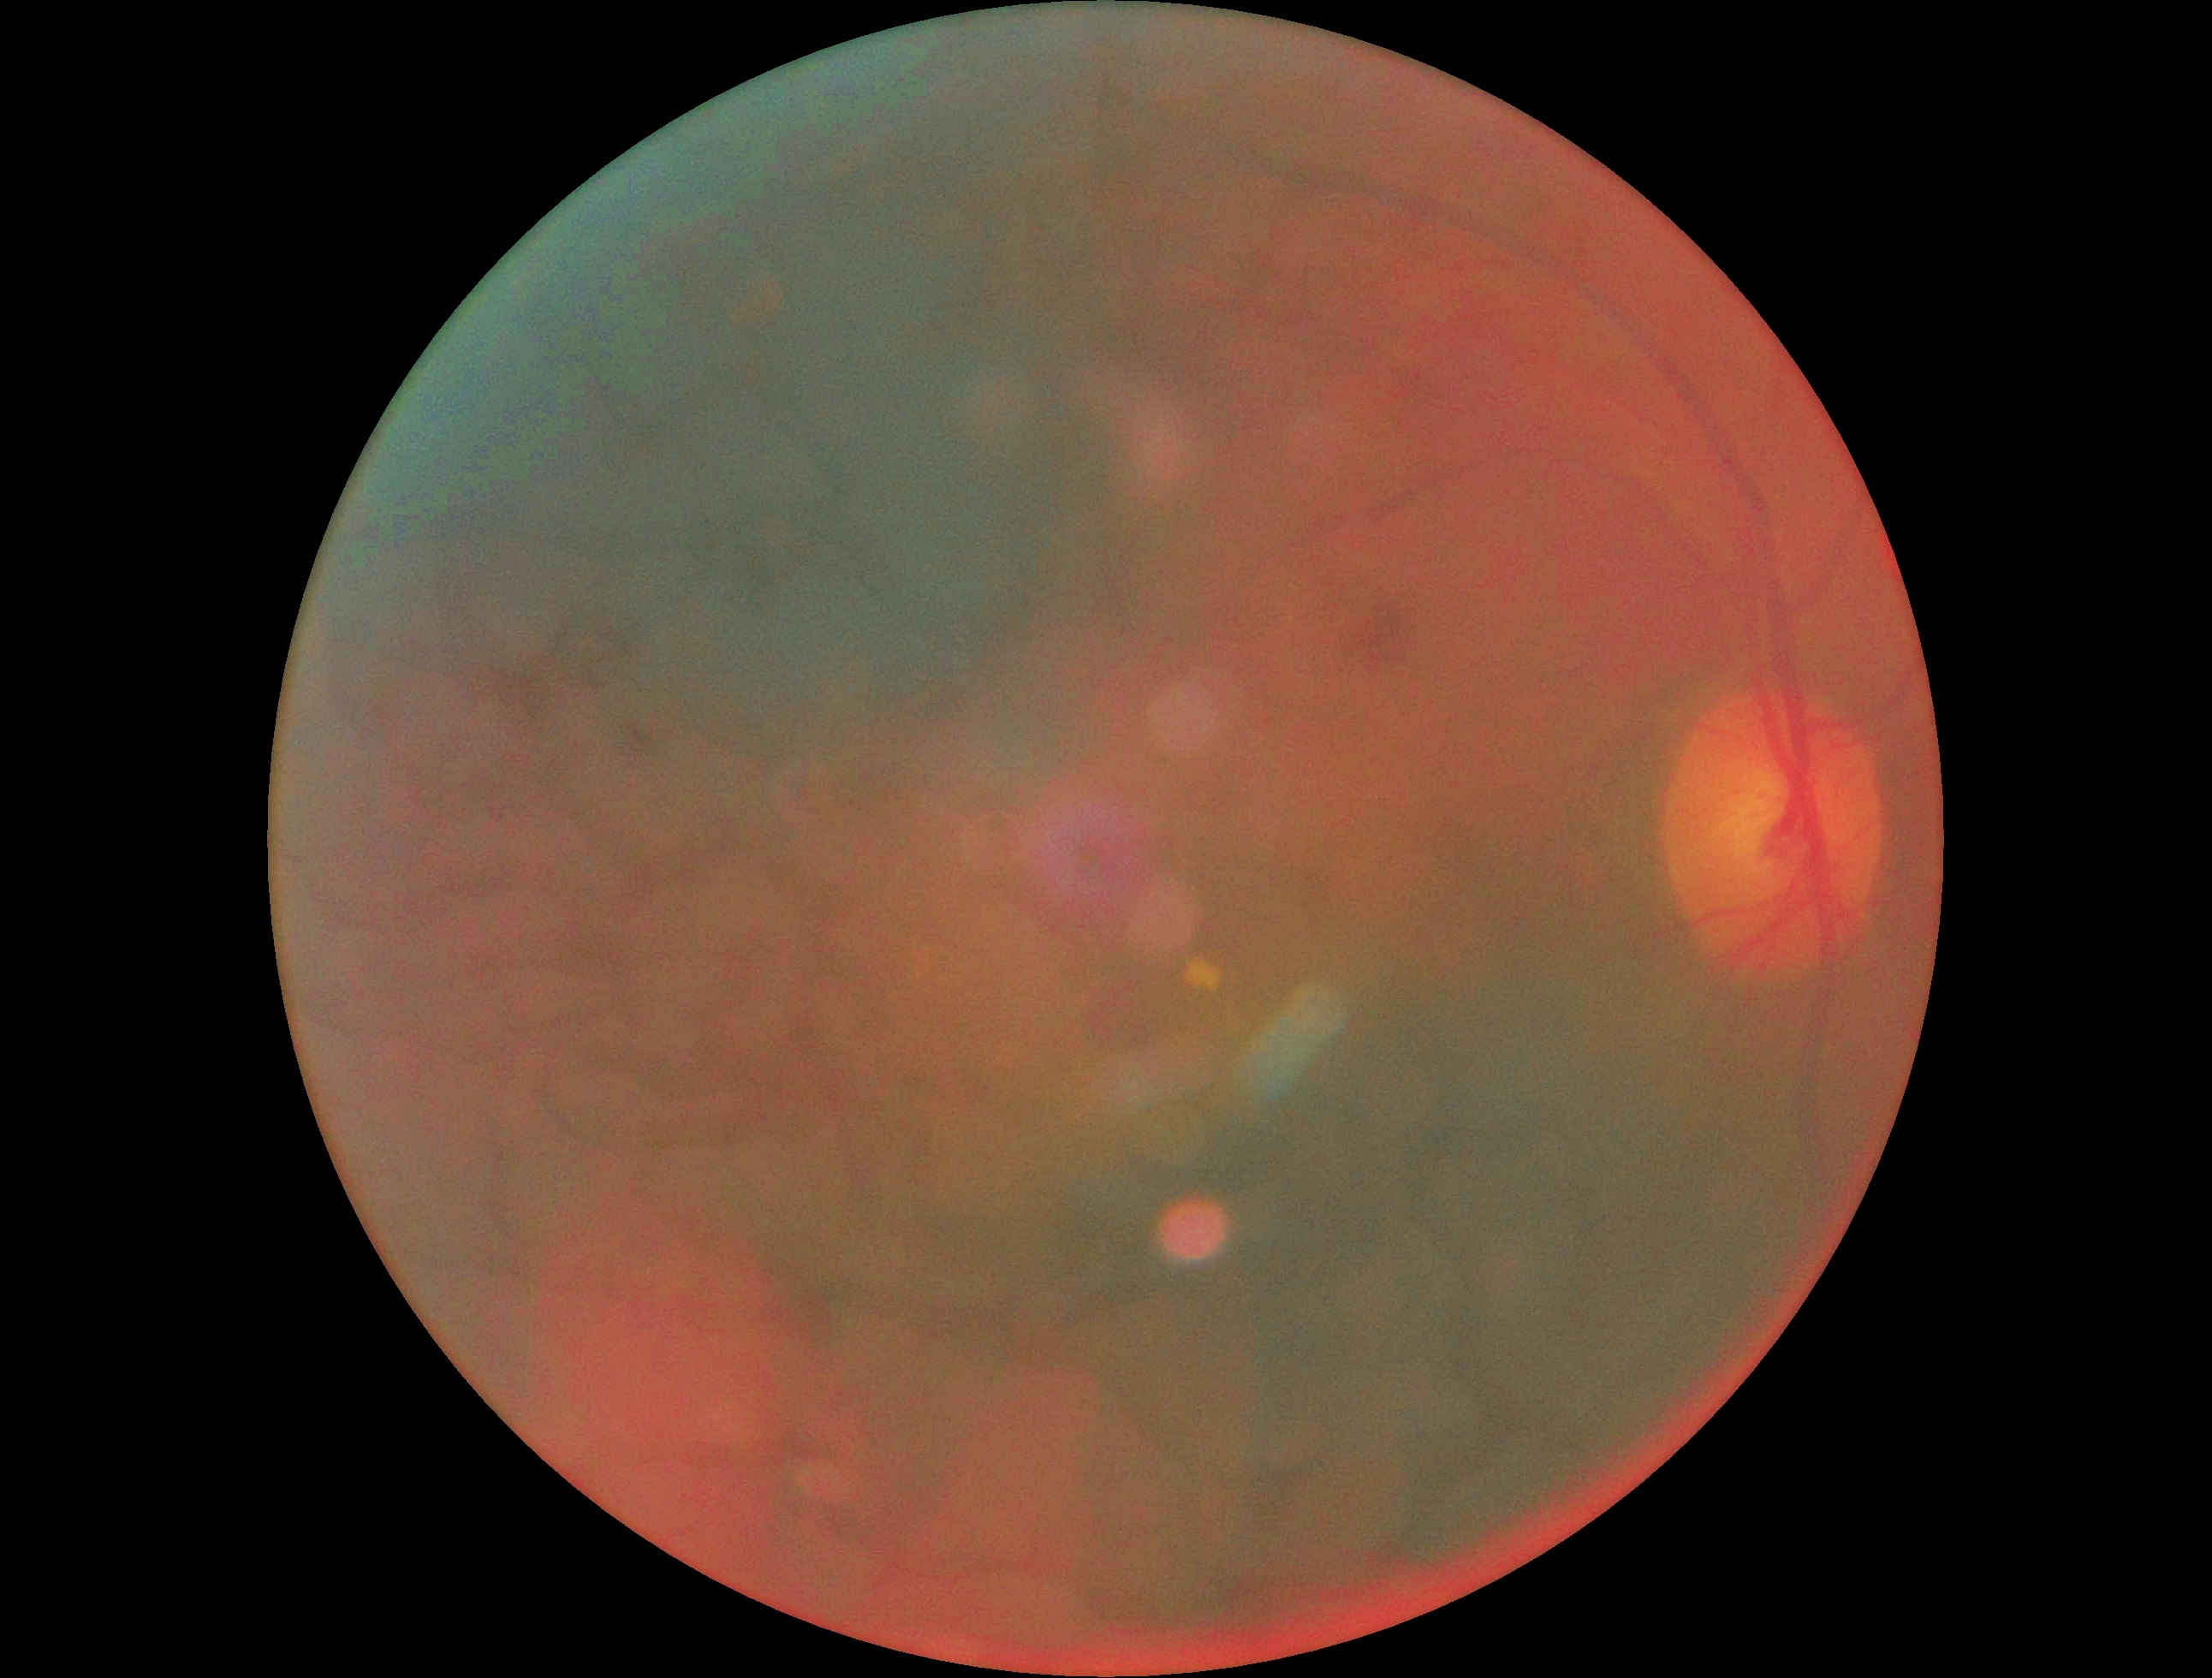
retinopathy grade=moderate non-proliferative diabetic retinopathy (2).